1240x1240px · captured with the Phoenix ICON (100° field of view) · infant wide-field fundus photograph:
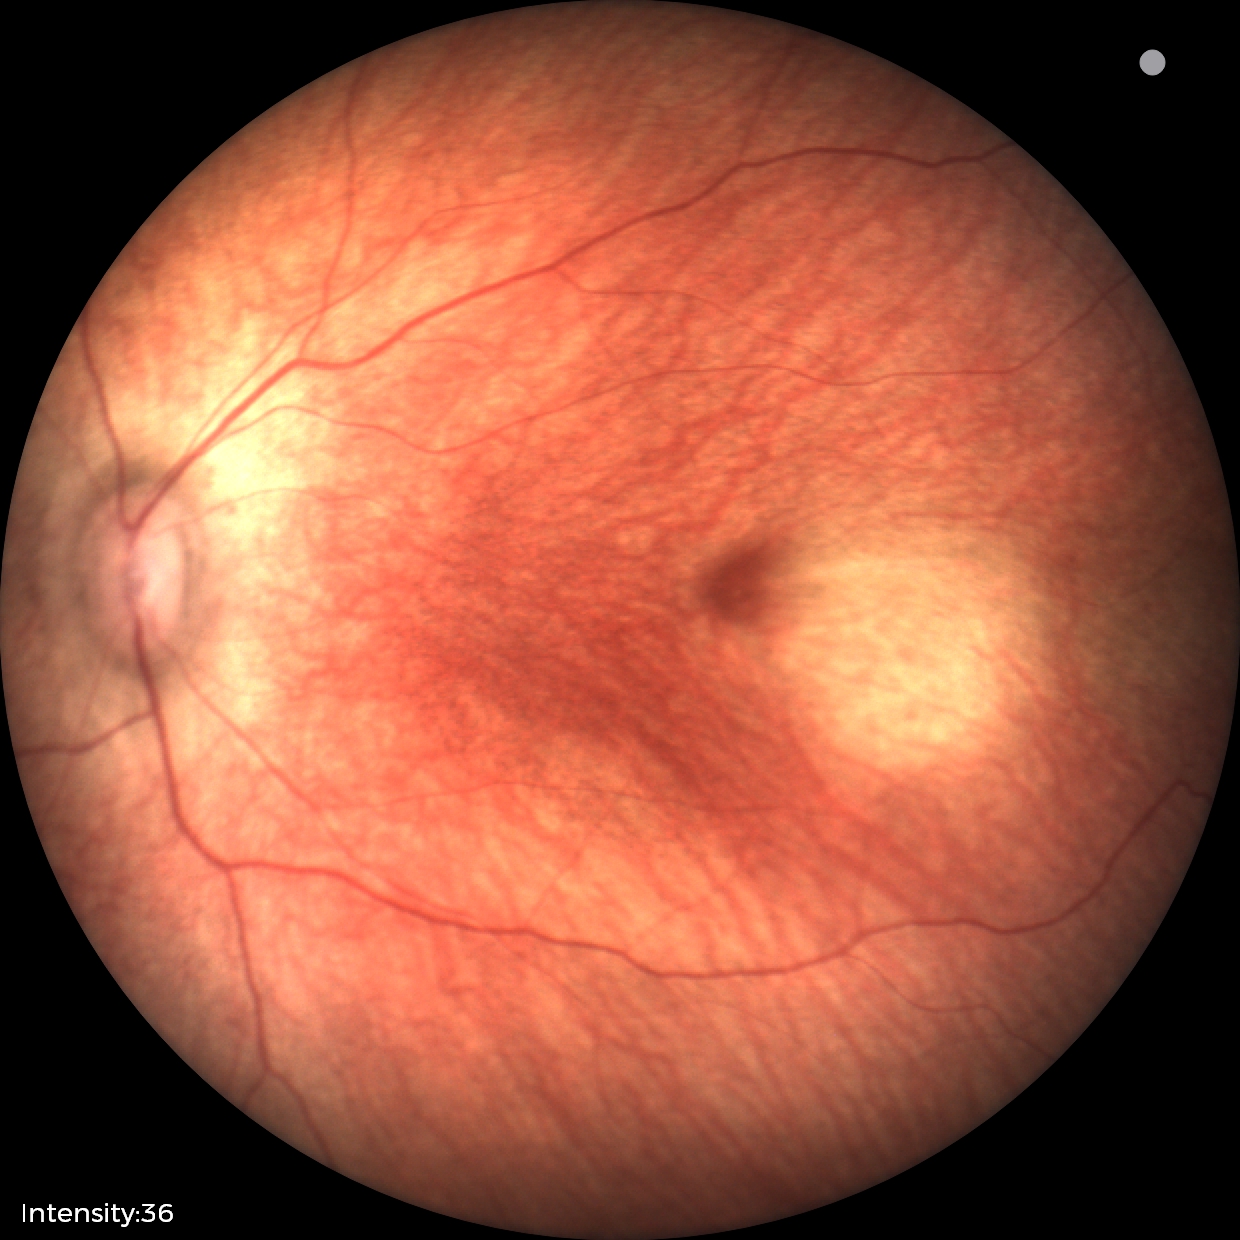

Screening diagnosis: no abnormal retinal findings.